Diabetic retinopathy graded by the modified Davis classification, nonmydriatic fundus photograph: 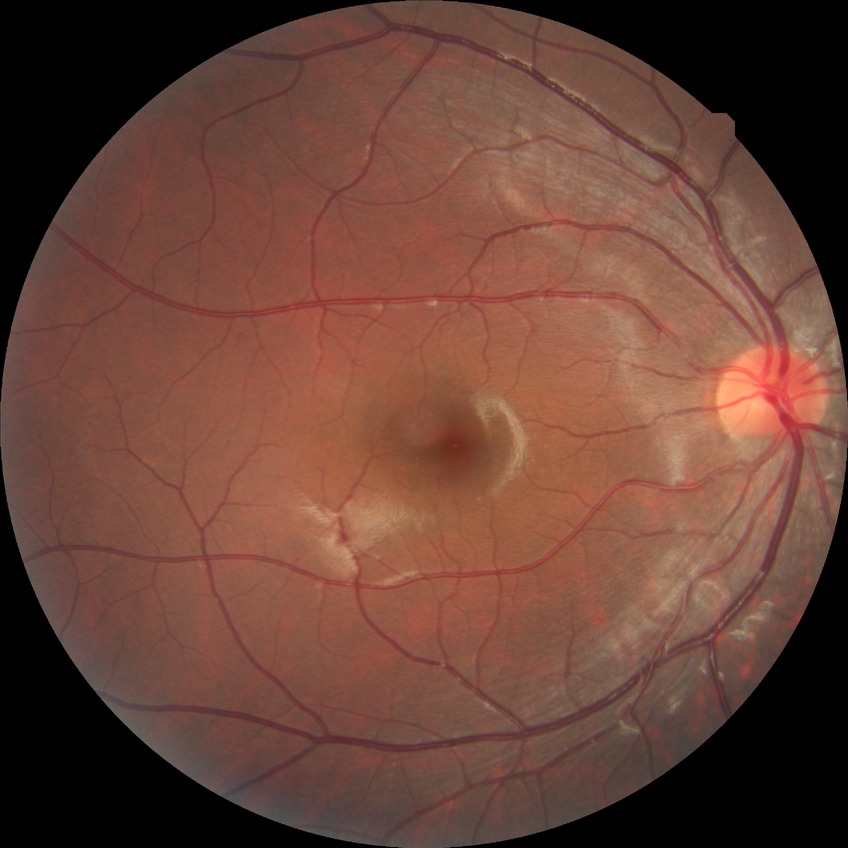
Modified Davis grade is NDR.